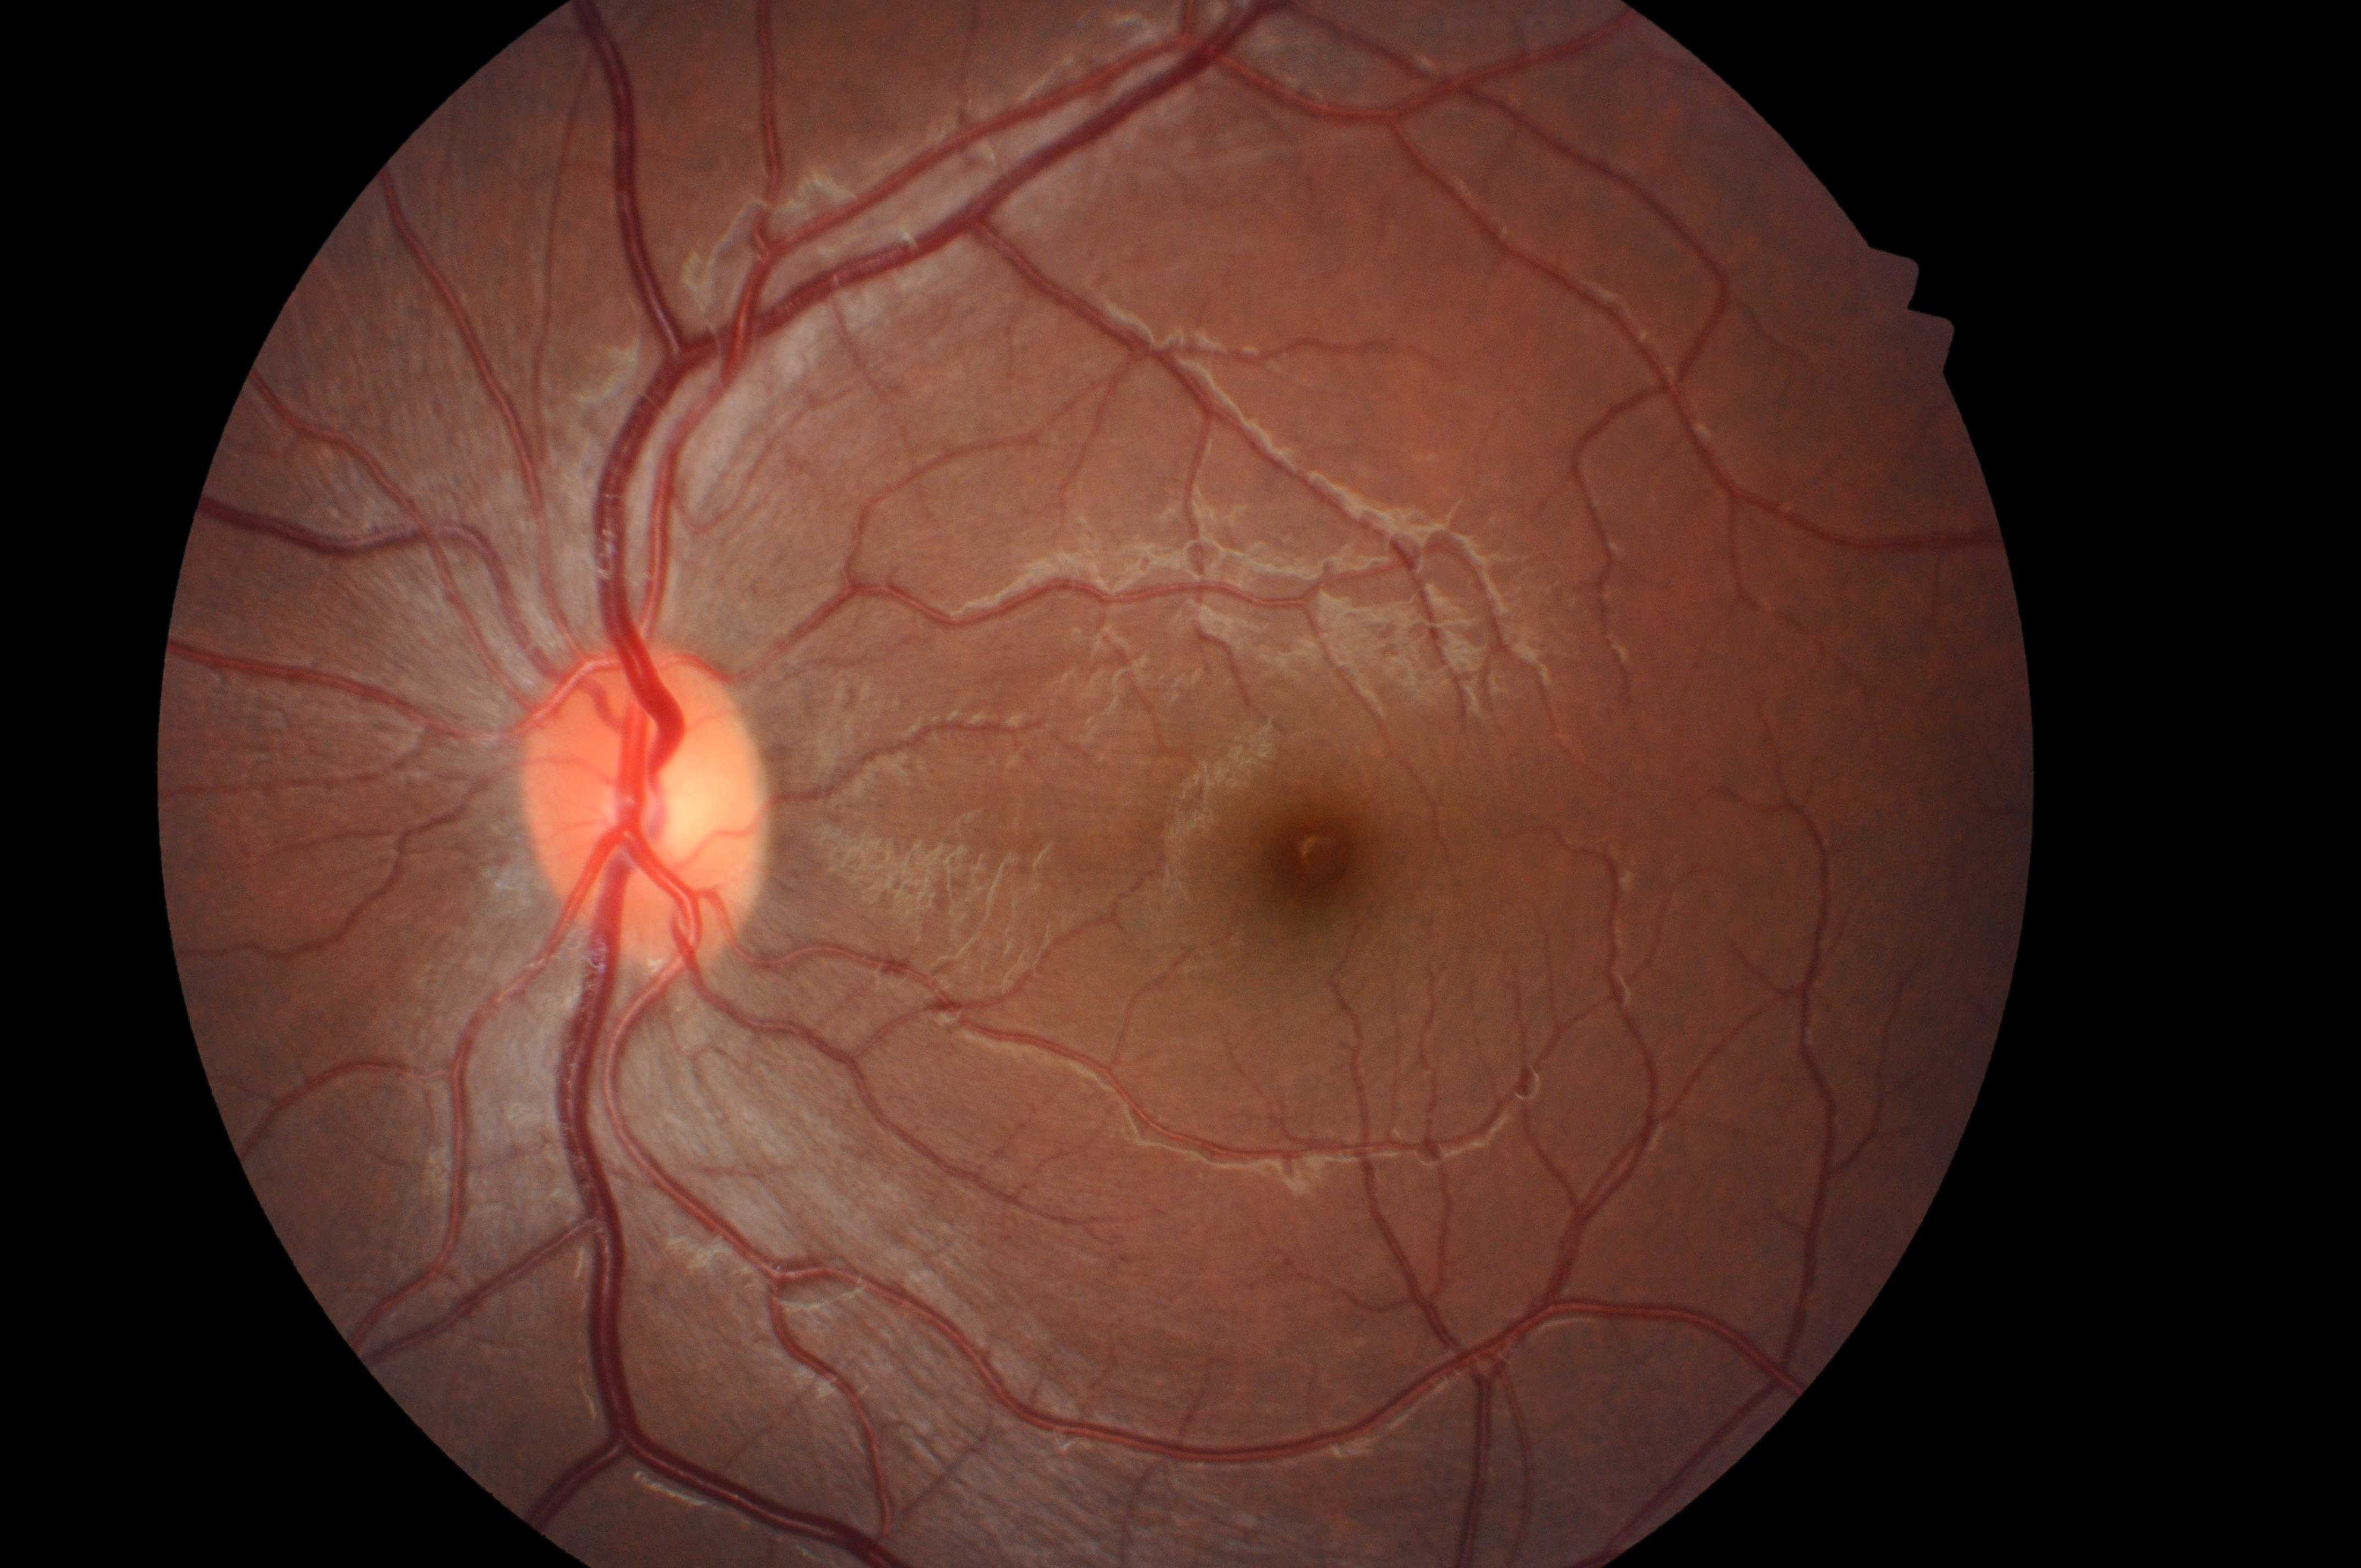

DME risk: no risk (grade 0). The optic nerve head is at x=641, y=812. Imaged eye: the left eye. DR stage: grade 0 (no apparent retinopathy). No diabetic retinopathy; no macular edema risk. The macular center is at x=1316, y=859.